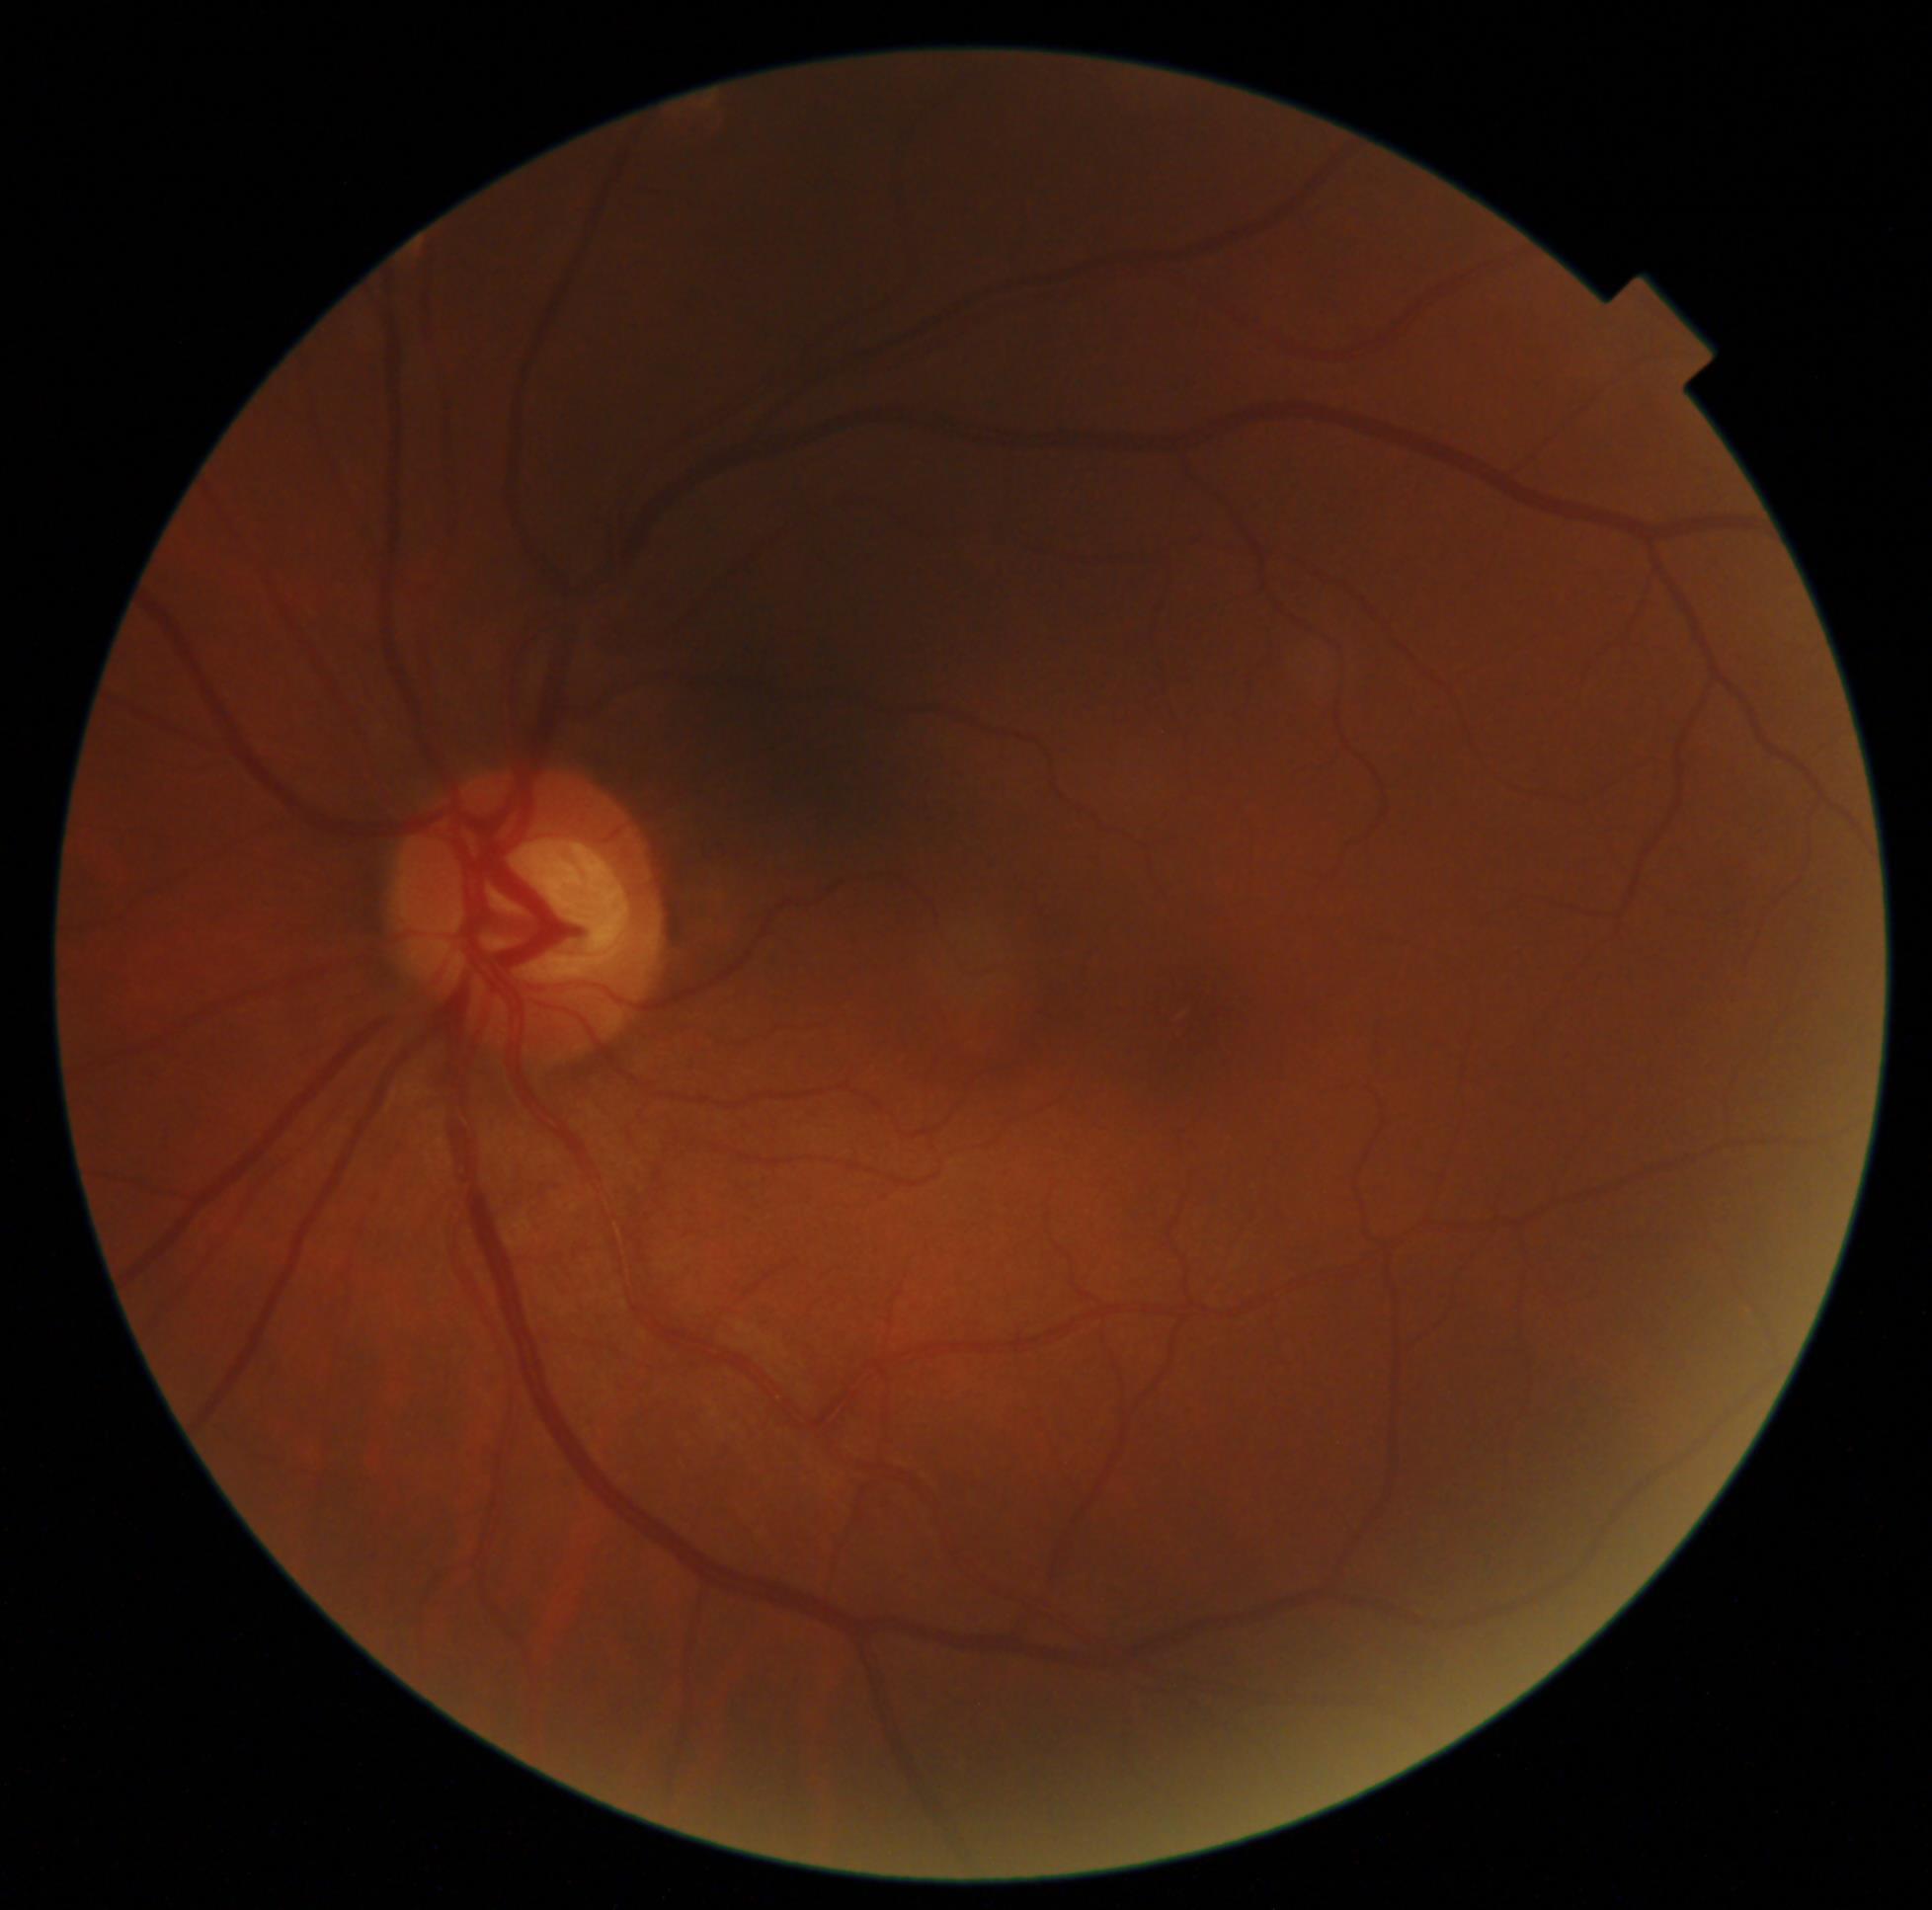
Annotations:
- diabetic retinopathy (DR) — no apparent retinopathy (grade 0) — no visible signs of diabetic retinopathy